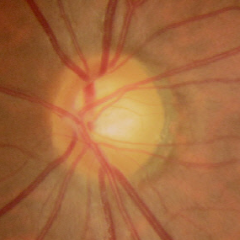

Optic nerve head appearance consistent with no glaucomatous changes.